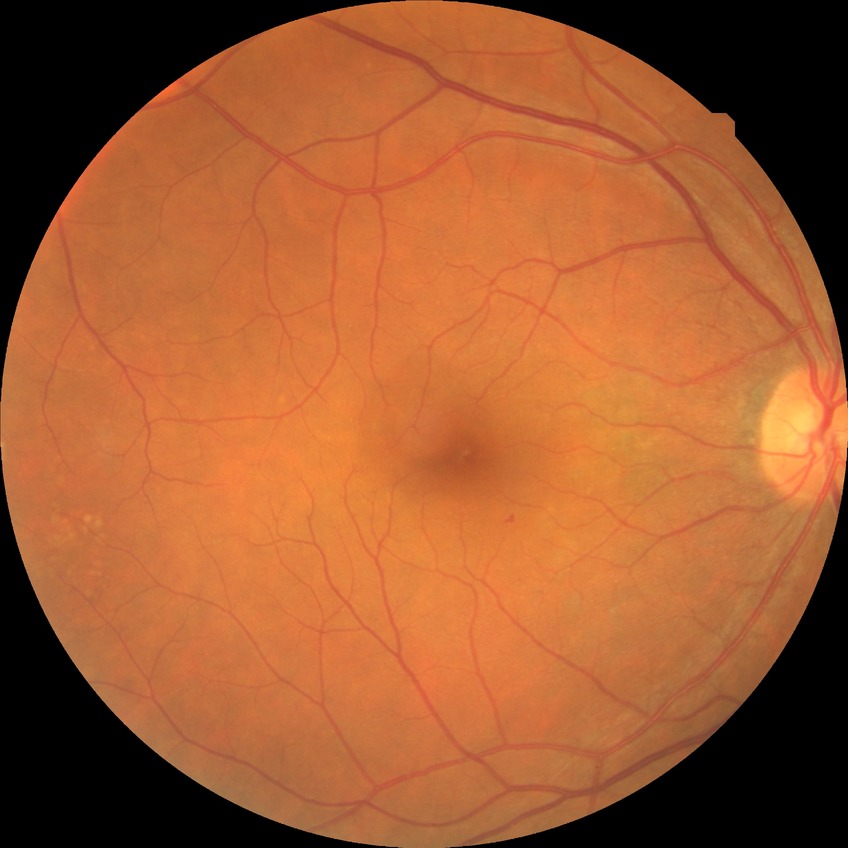
diabetic retinopathy severity = no diabetic retinopathy